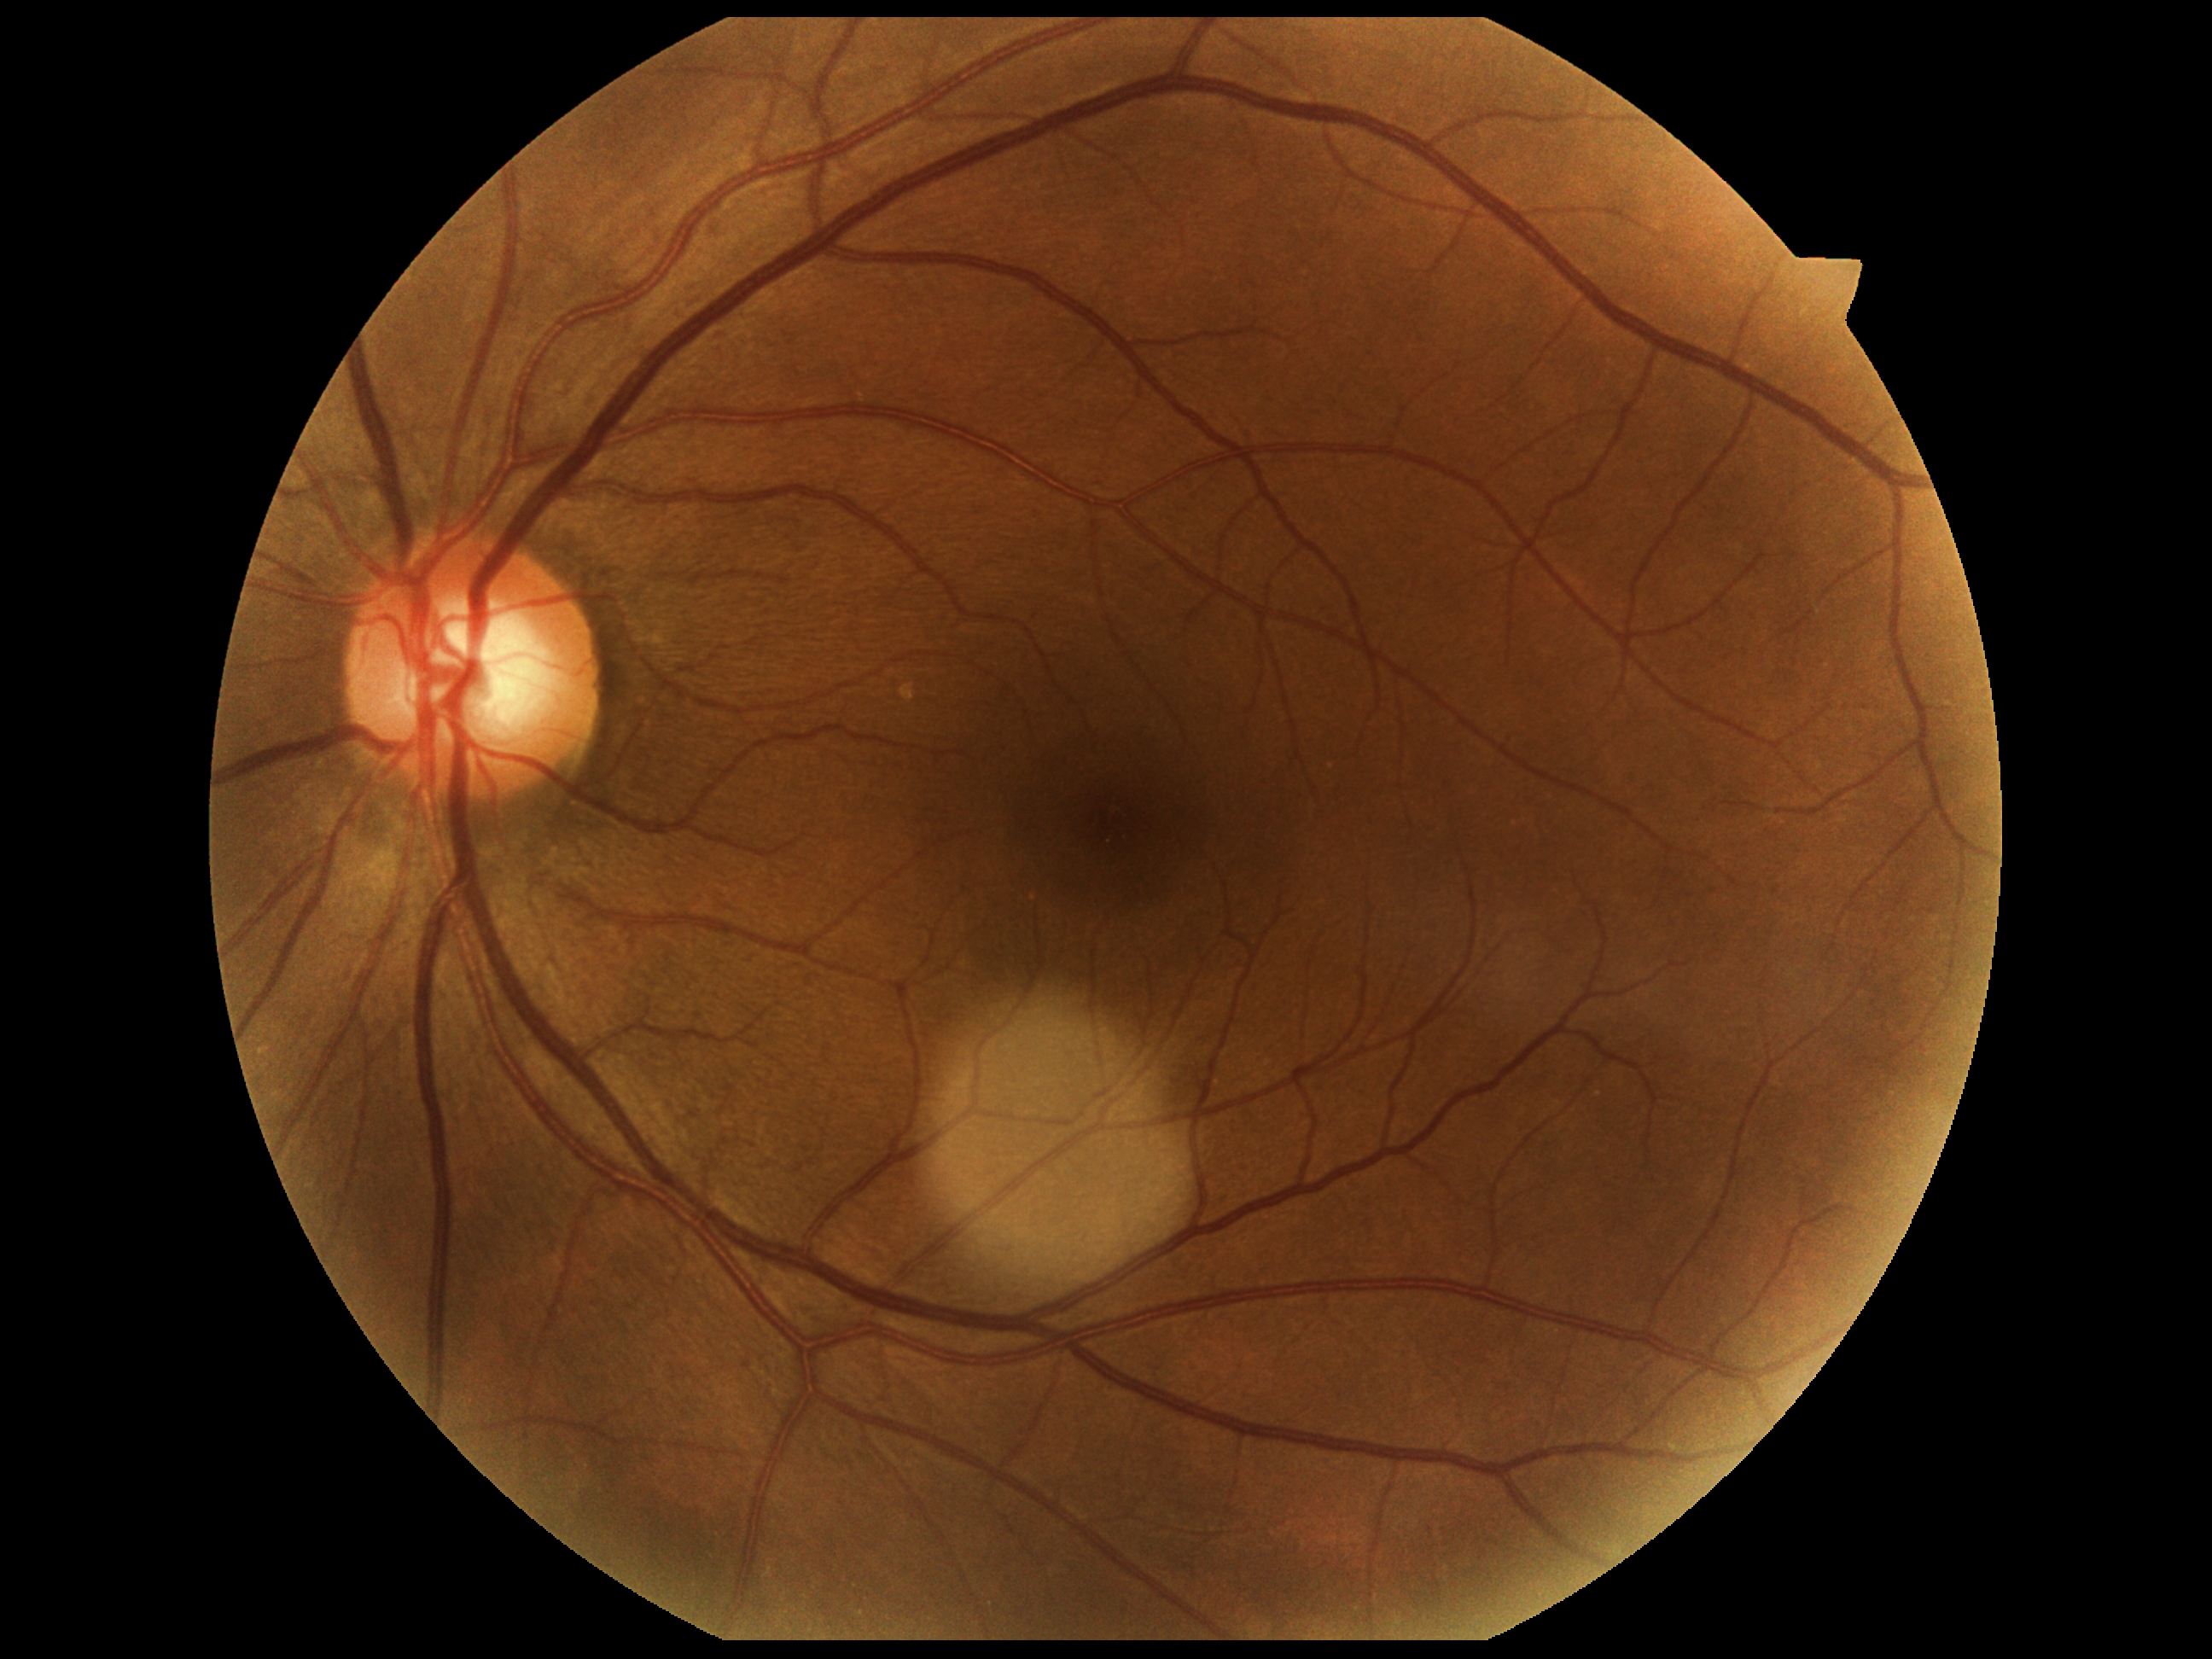
Retinopathy: grade 0 — no visible signs of diabetic retinopathy.